Wide-field contact fundus photograph of an infant.
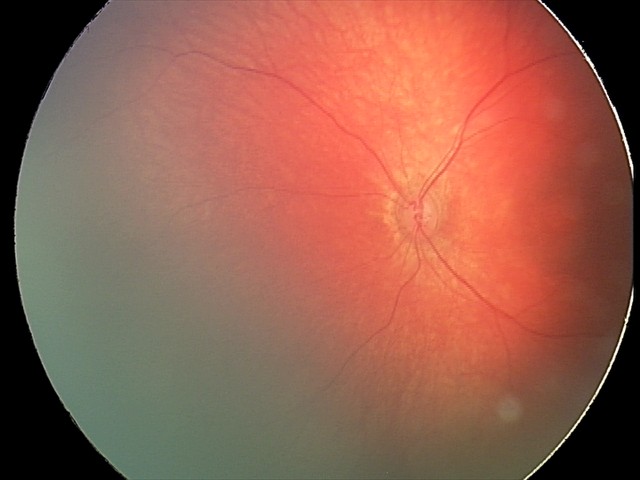 Screening series with retinal hemorrhages.